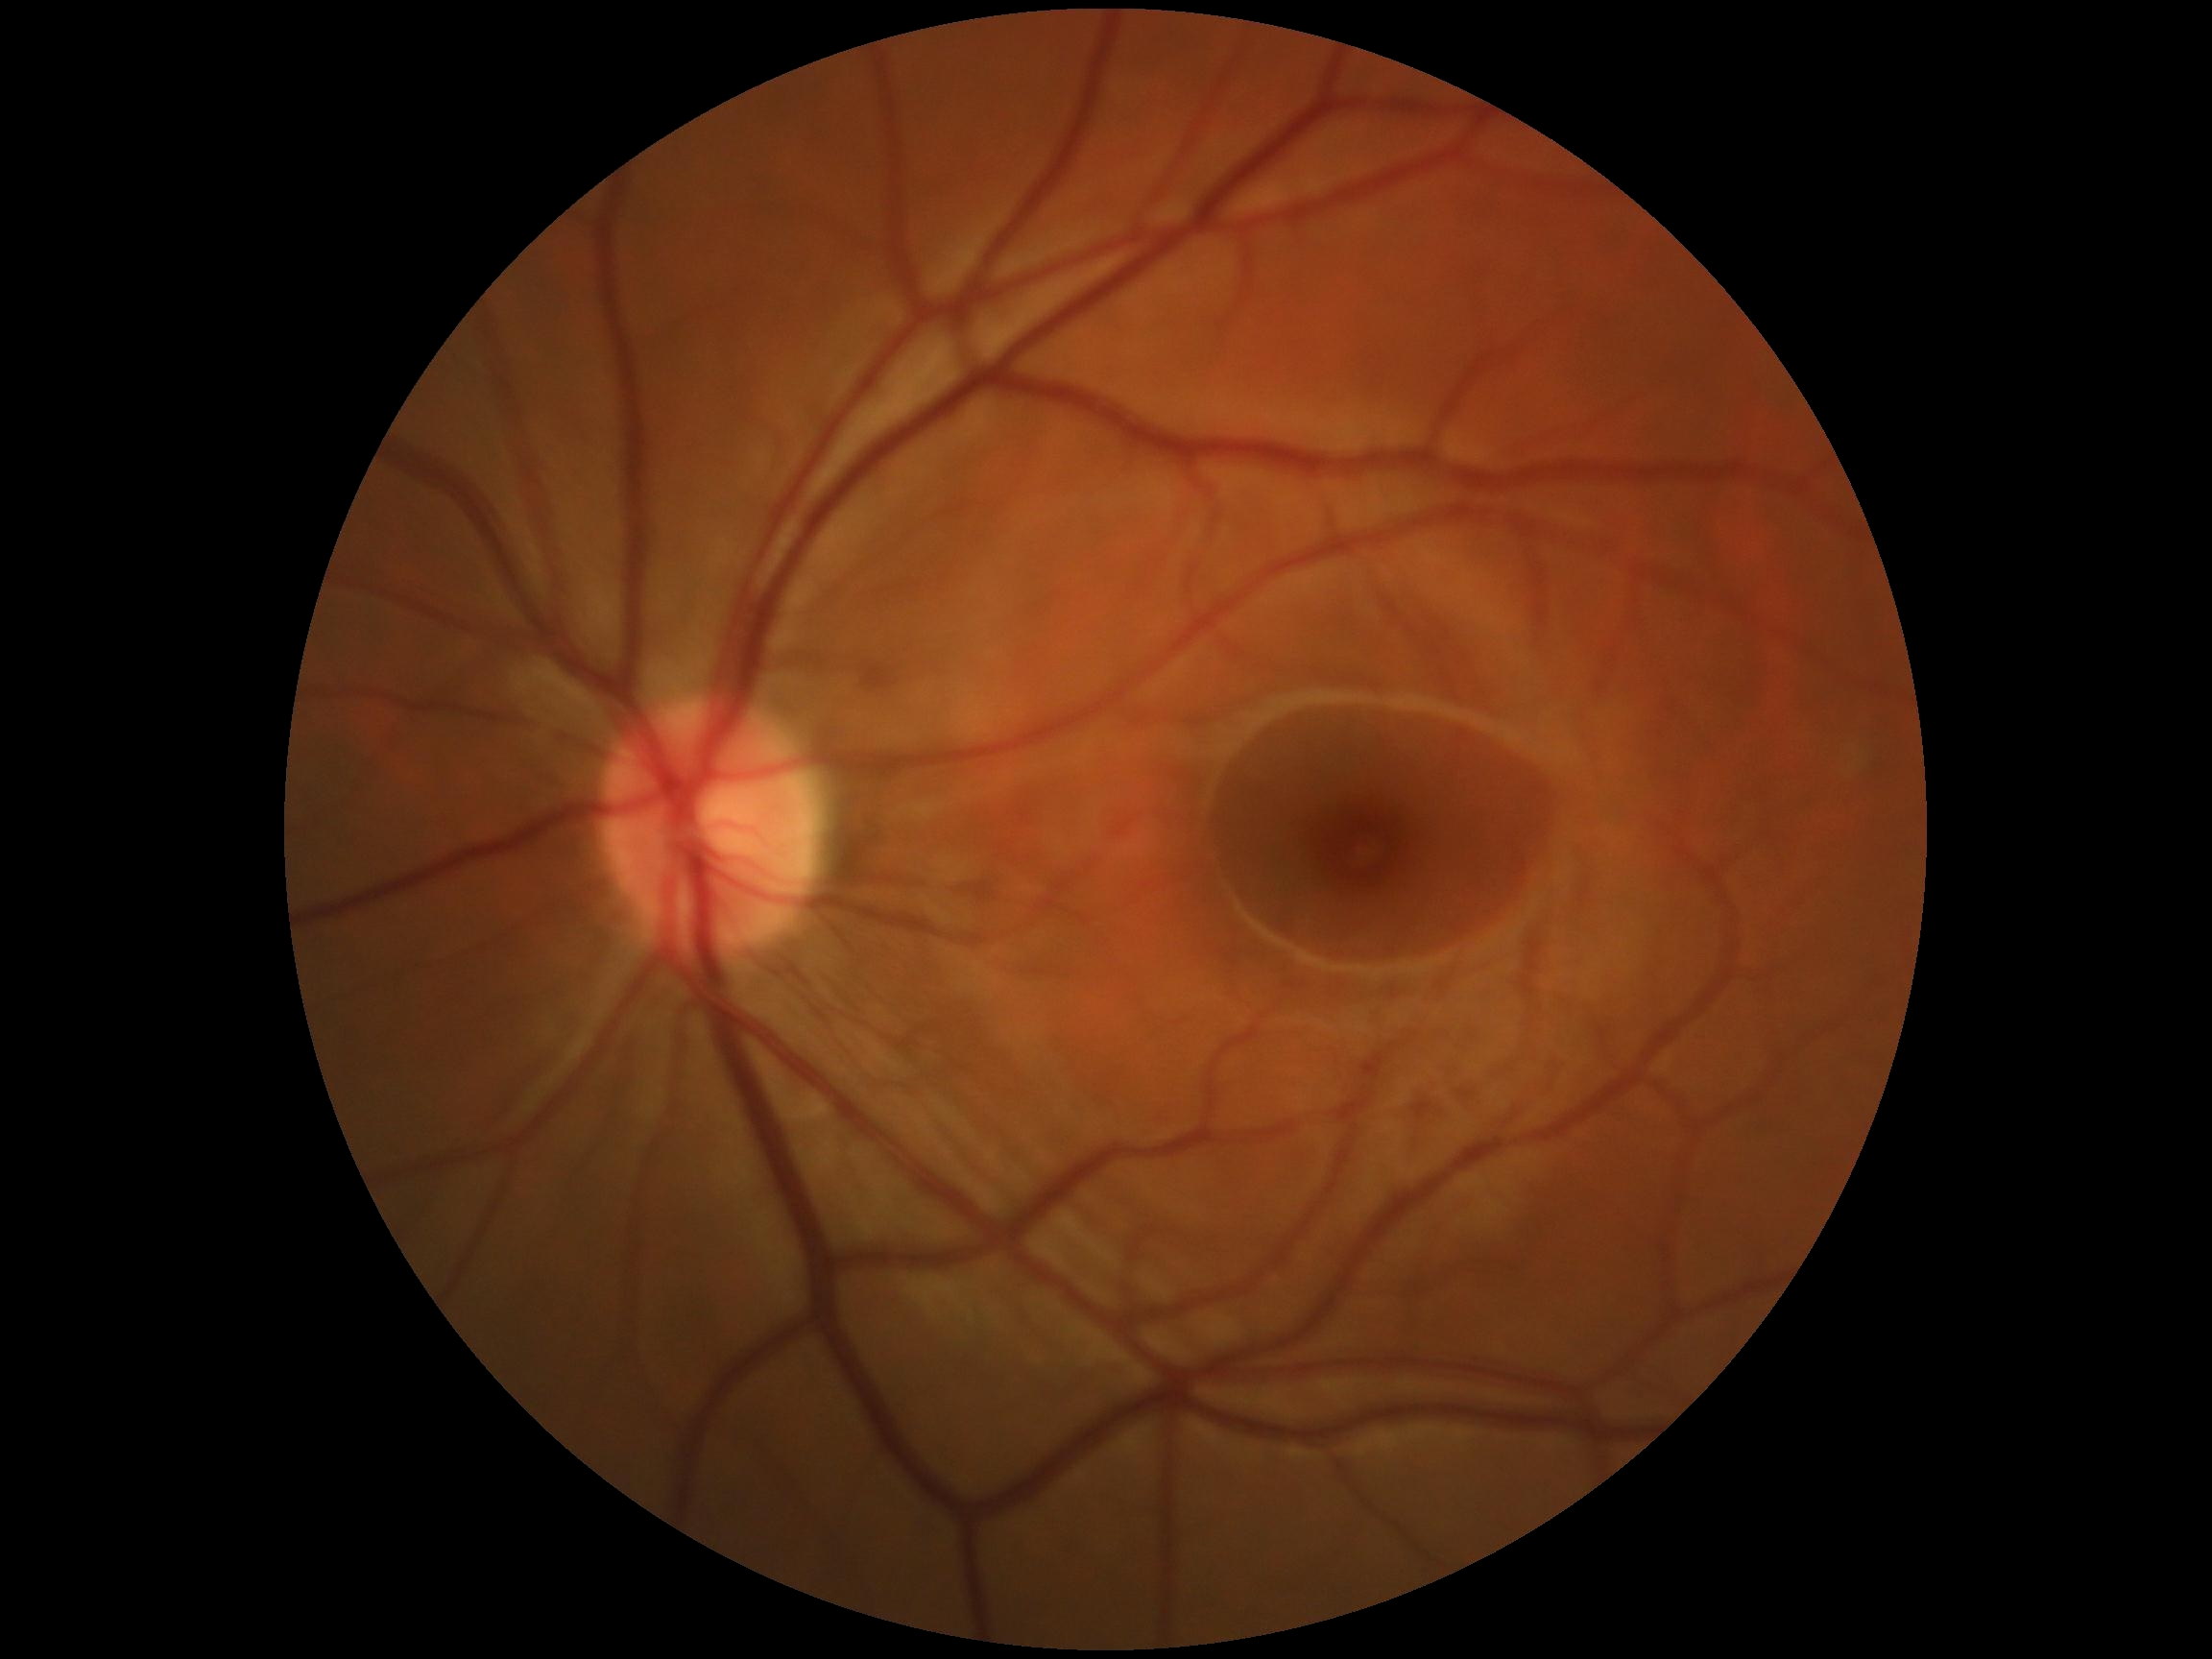 Diabetic retinopathy (DR) is no apparent retinopathy (grade 0) — no visible signs of diabetic retinopathy.